Nonmydriatic. Image size 848x848. Graded on the modified Davis scale:
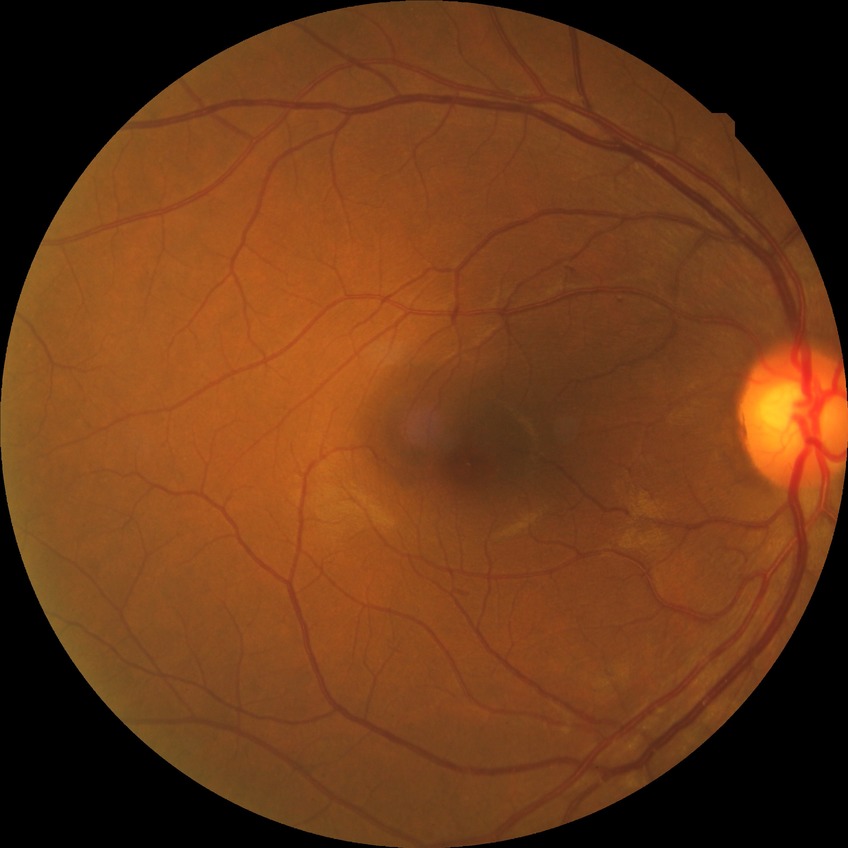

diabetic retinopathy (DR) = simple diabetic retinopathy (SDR).